CFP · 2184x1690 · 45° field of view: 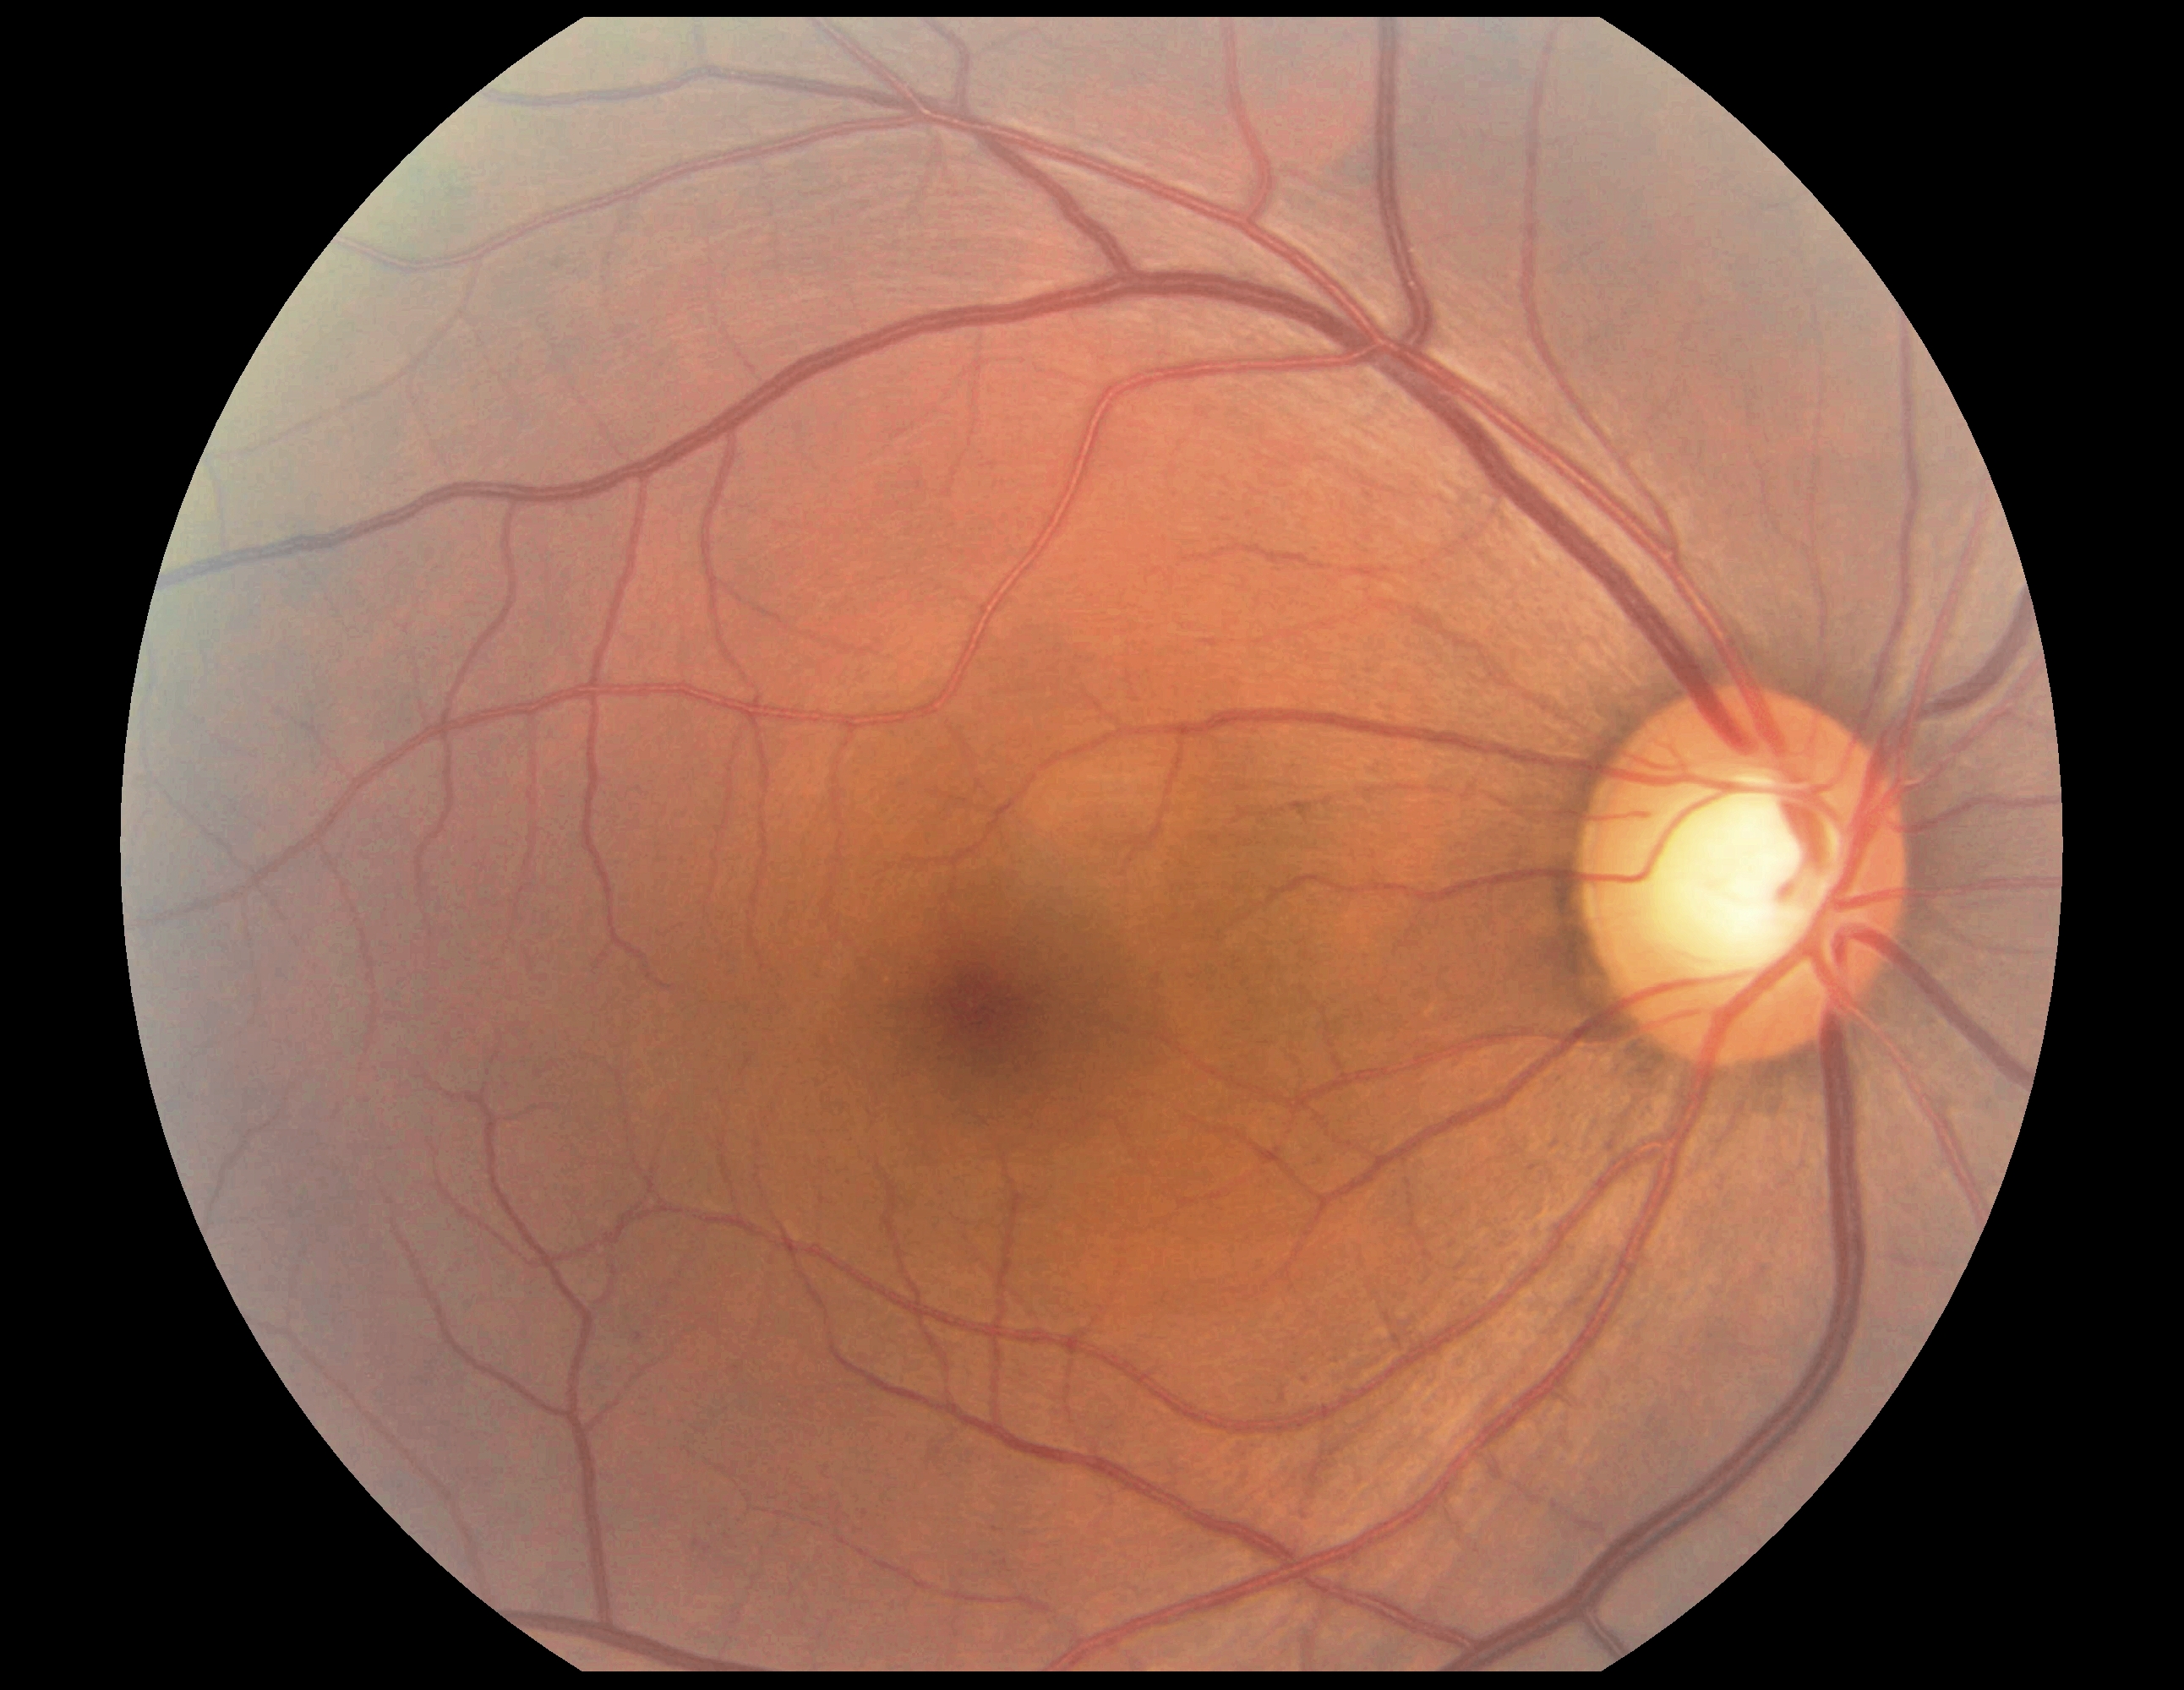
diabetic retinopathy grade: no apparent diabetic retinopathy (0); DR impression: no signs of DR.